Pediatric retinal photograph (wide-field) · 1240 x 1240 pixels.
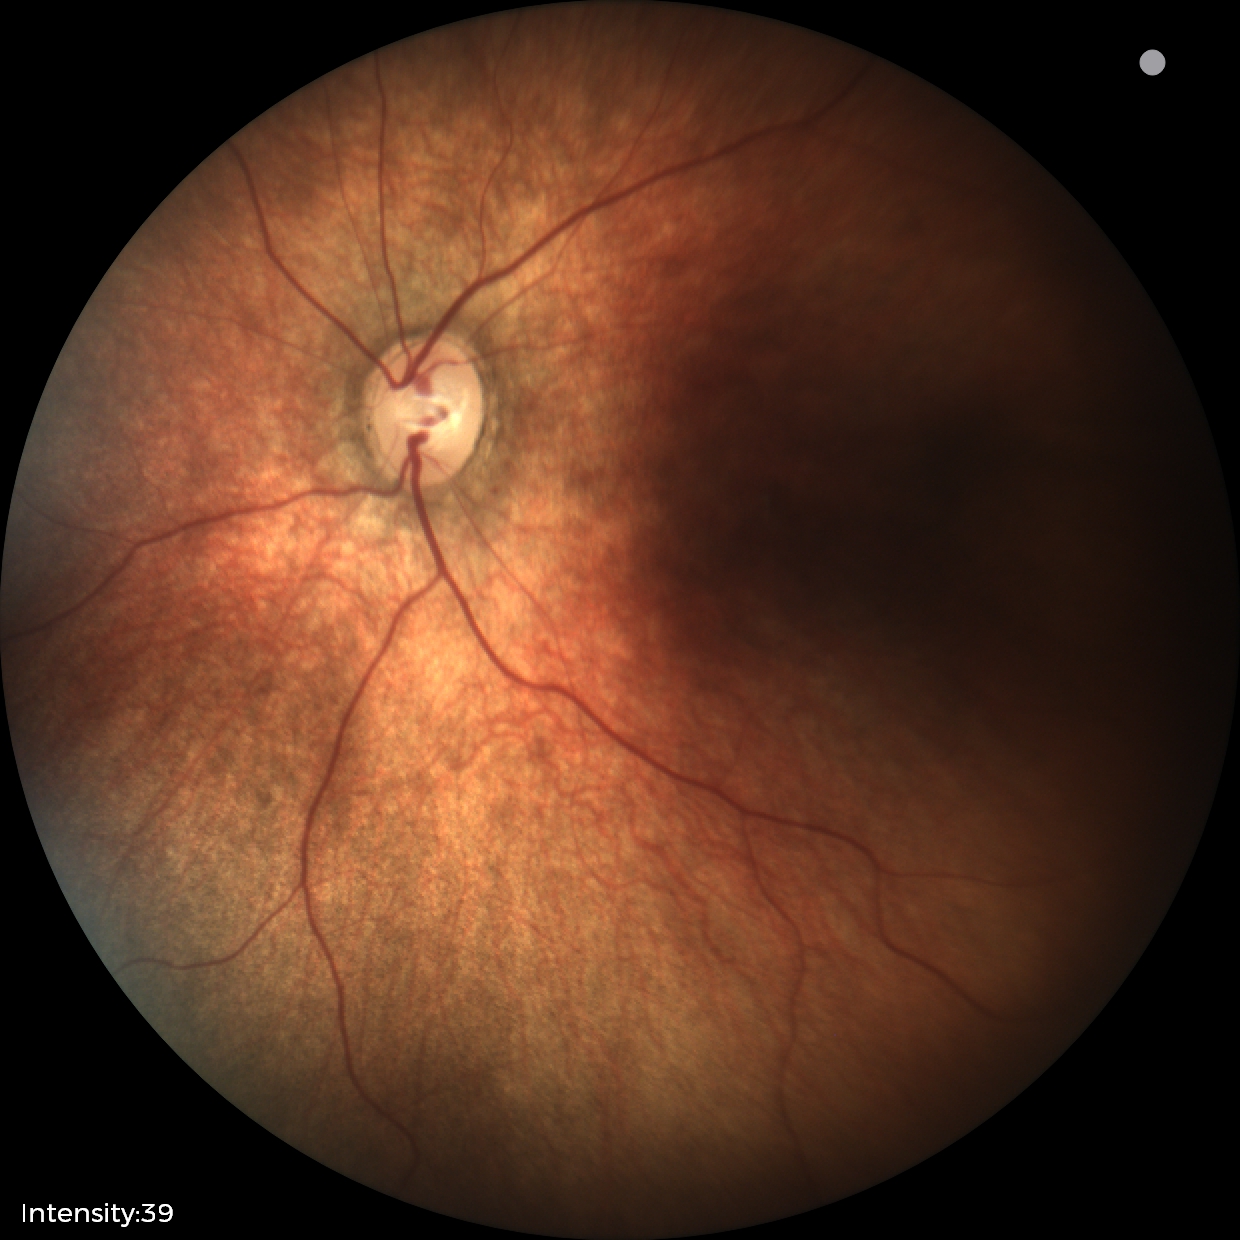

Physiological retinal appearance for postconceptual age.